Color fundus photograph. 512x512px:
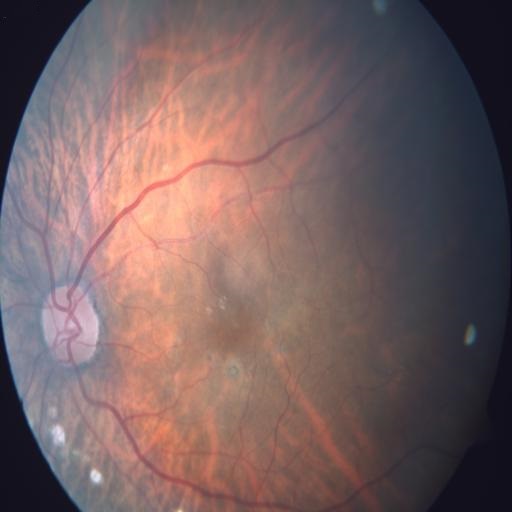
Diagnoses: RPEC (retinal pigment epithelium changes); MYA (myopia); TSLN (tessellation).